Wide-field fundus photograph of an infant — 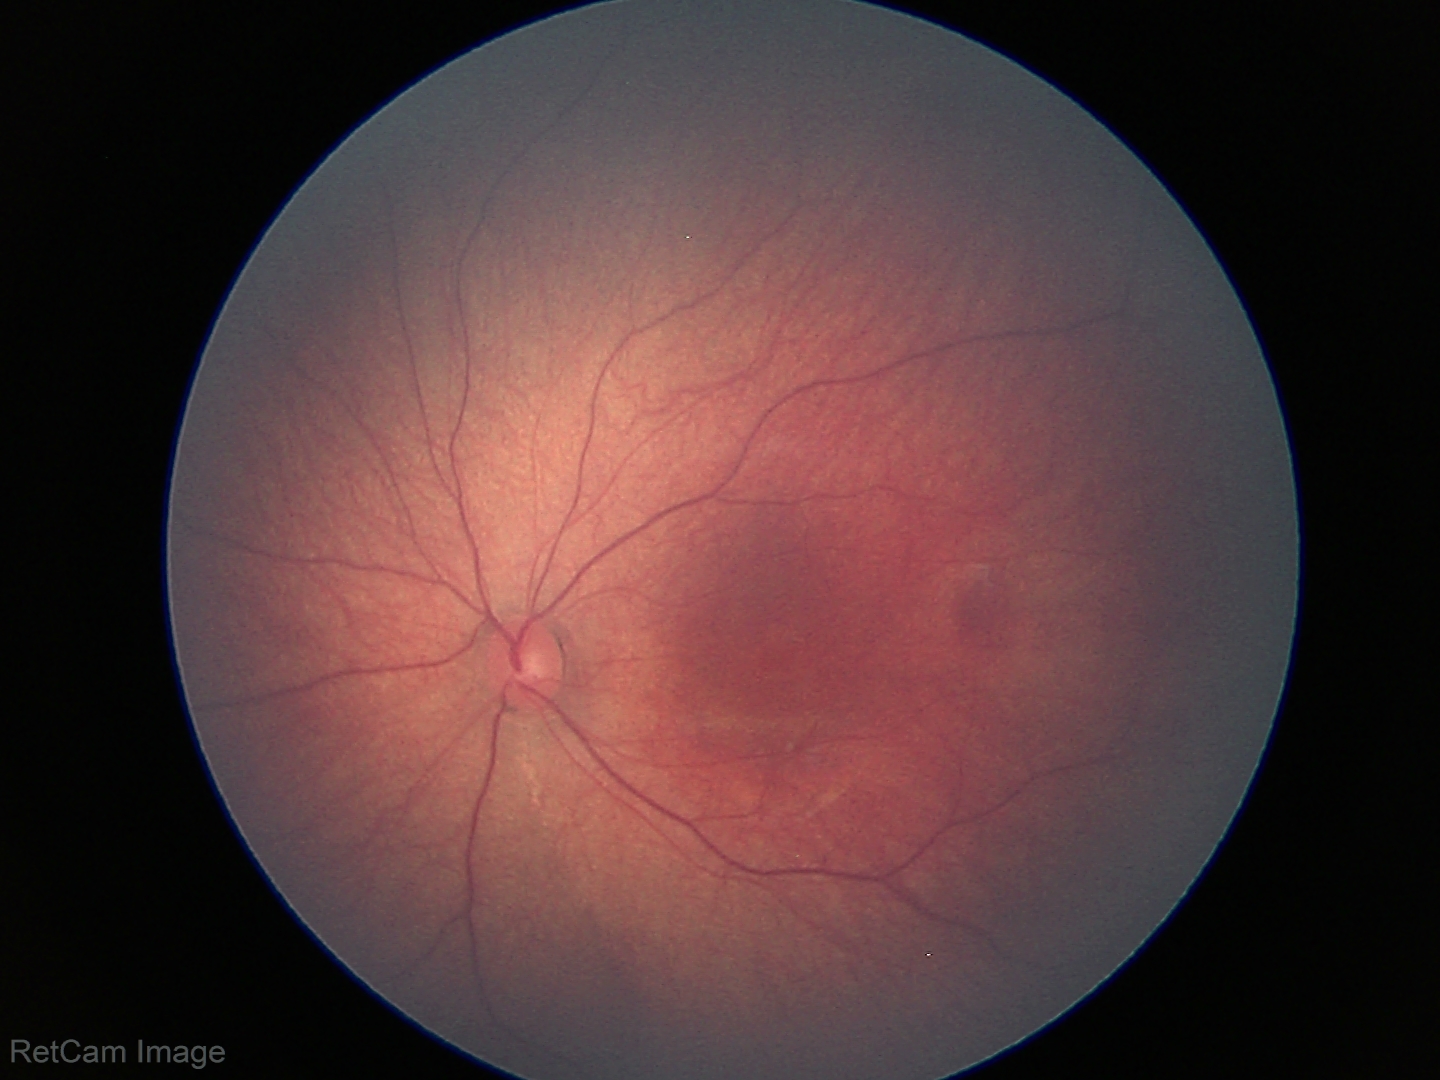

Q: What was the screening finding?
A: physiological appearance with no retinal pathology